Color fundus photograph — 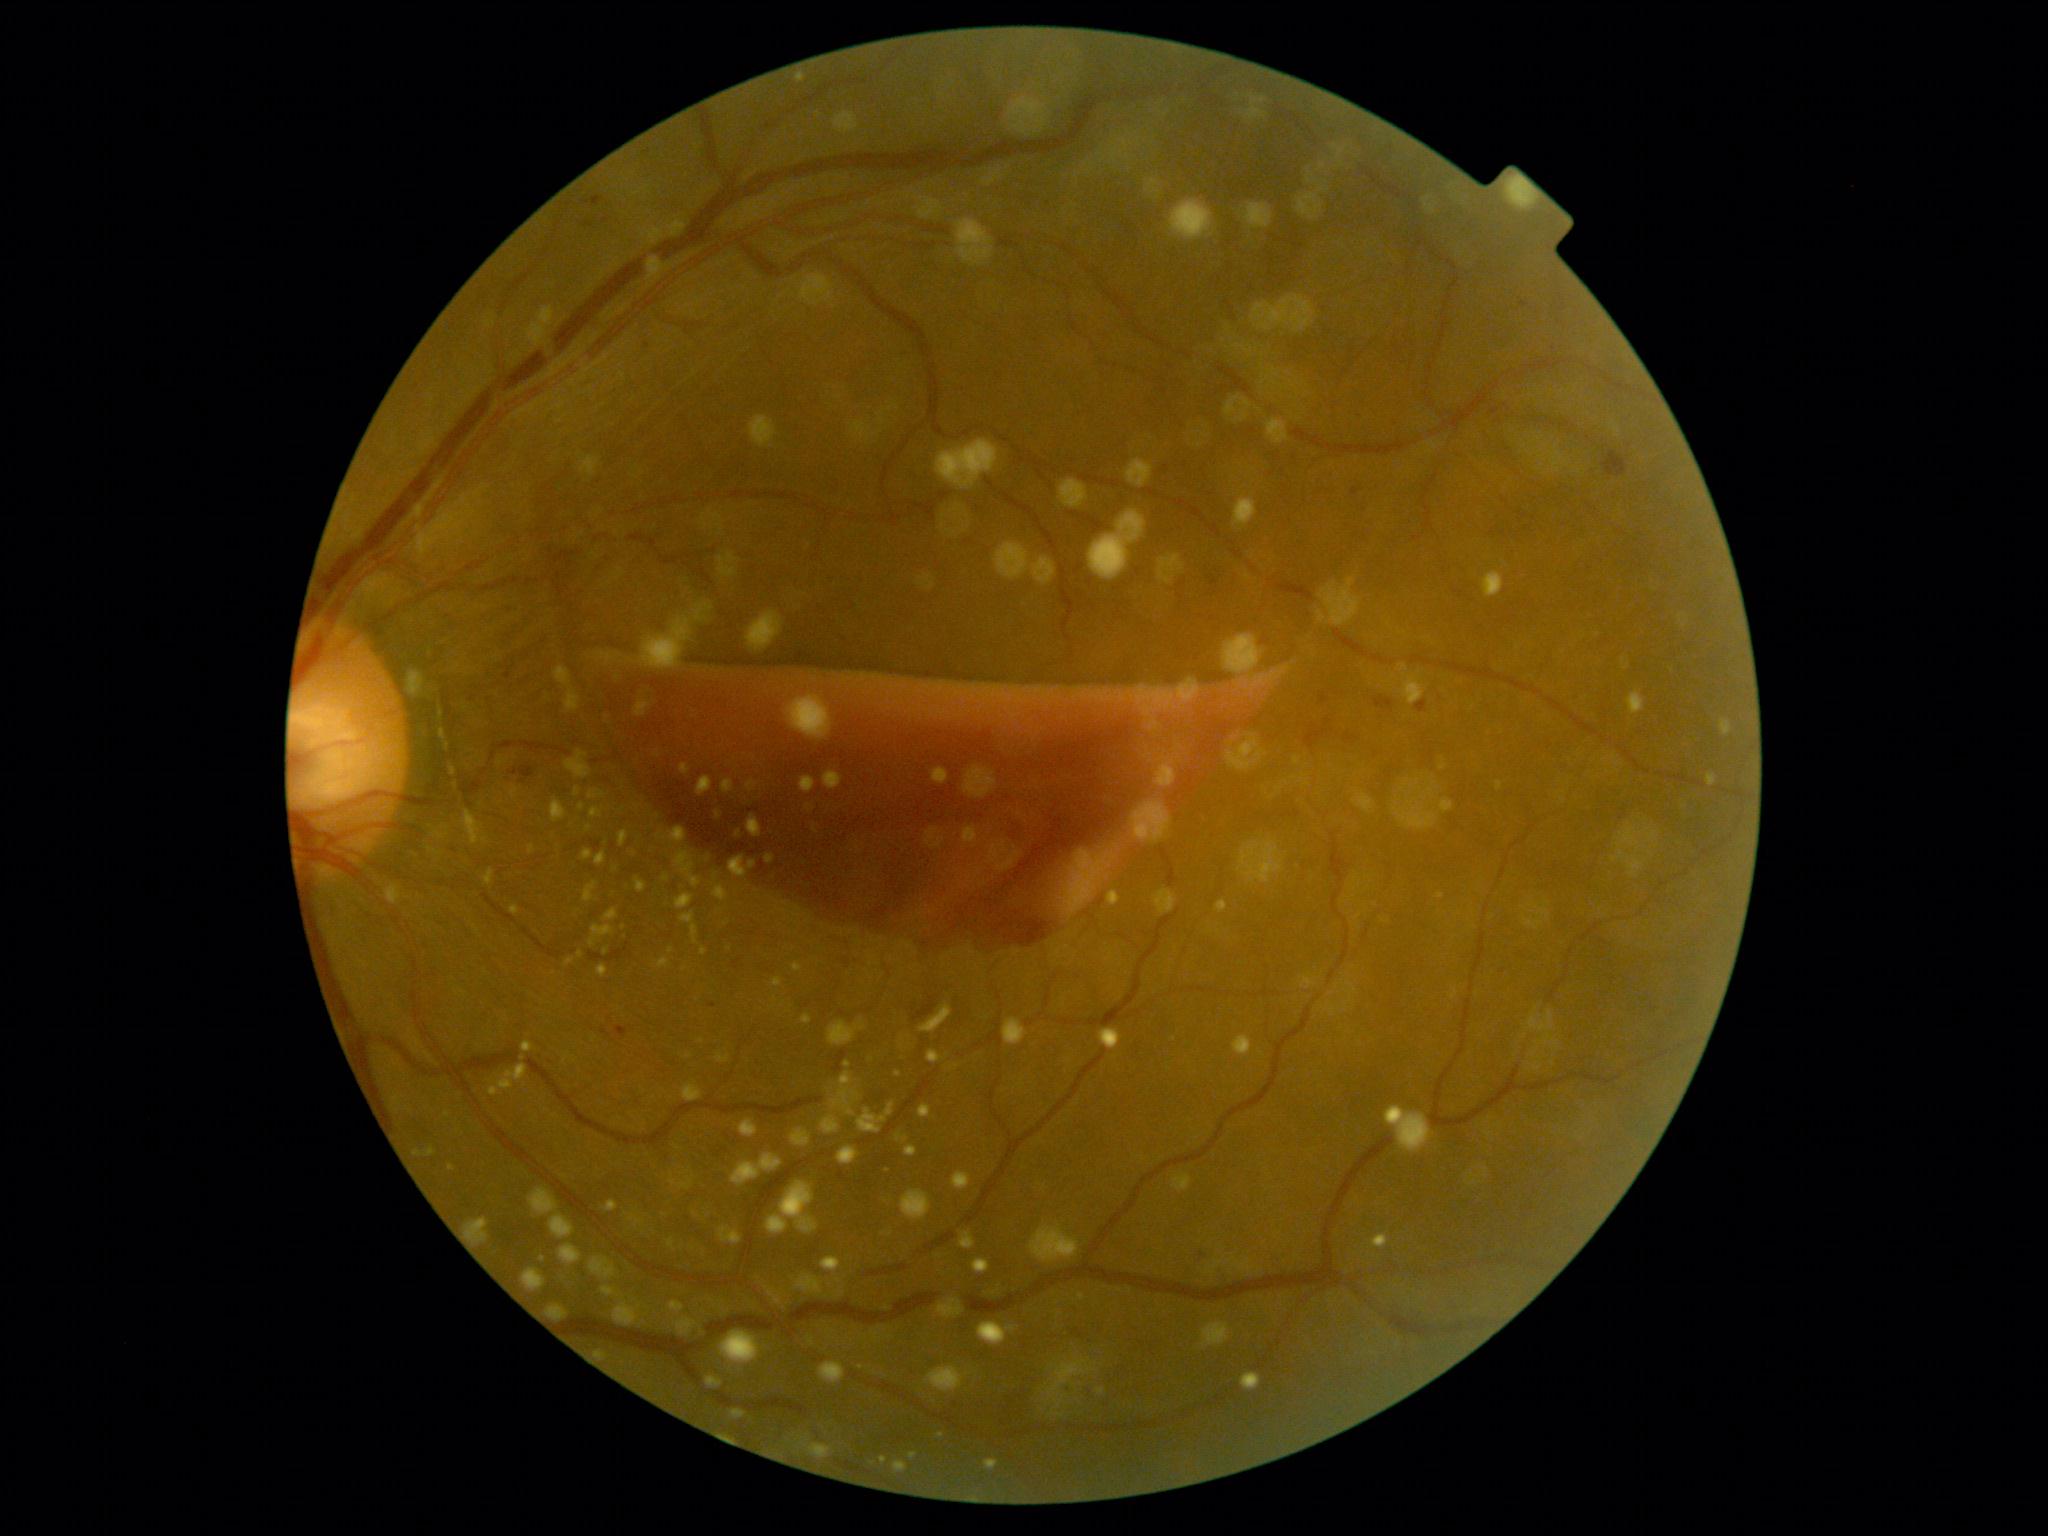

Diabetic retinopathy (DR): grade 4 (PDR).